Color fundus image: 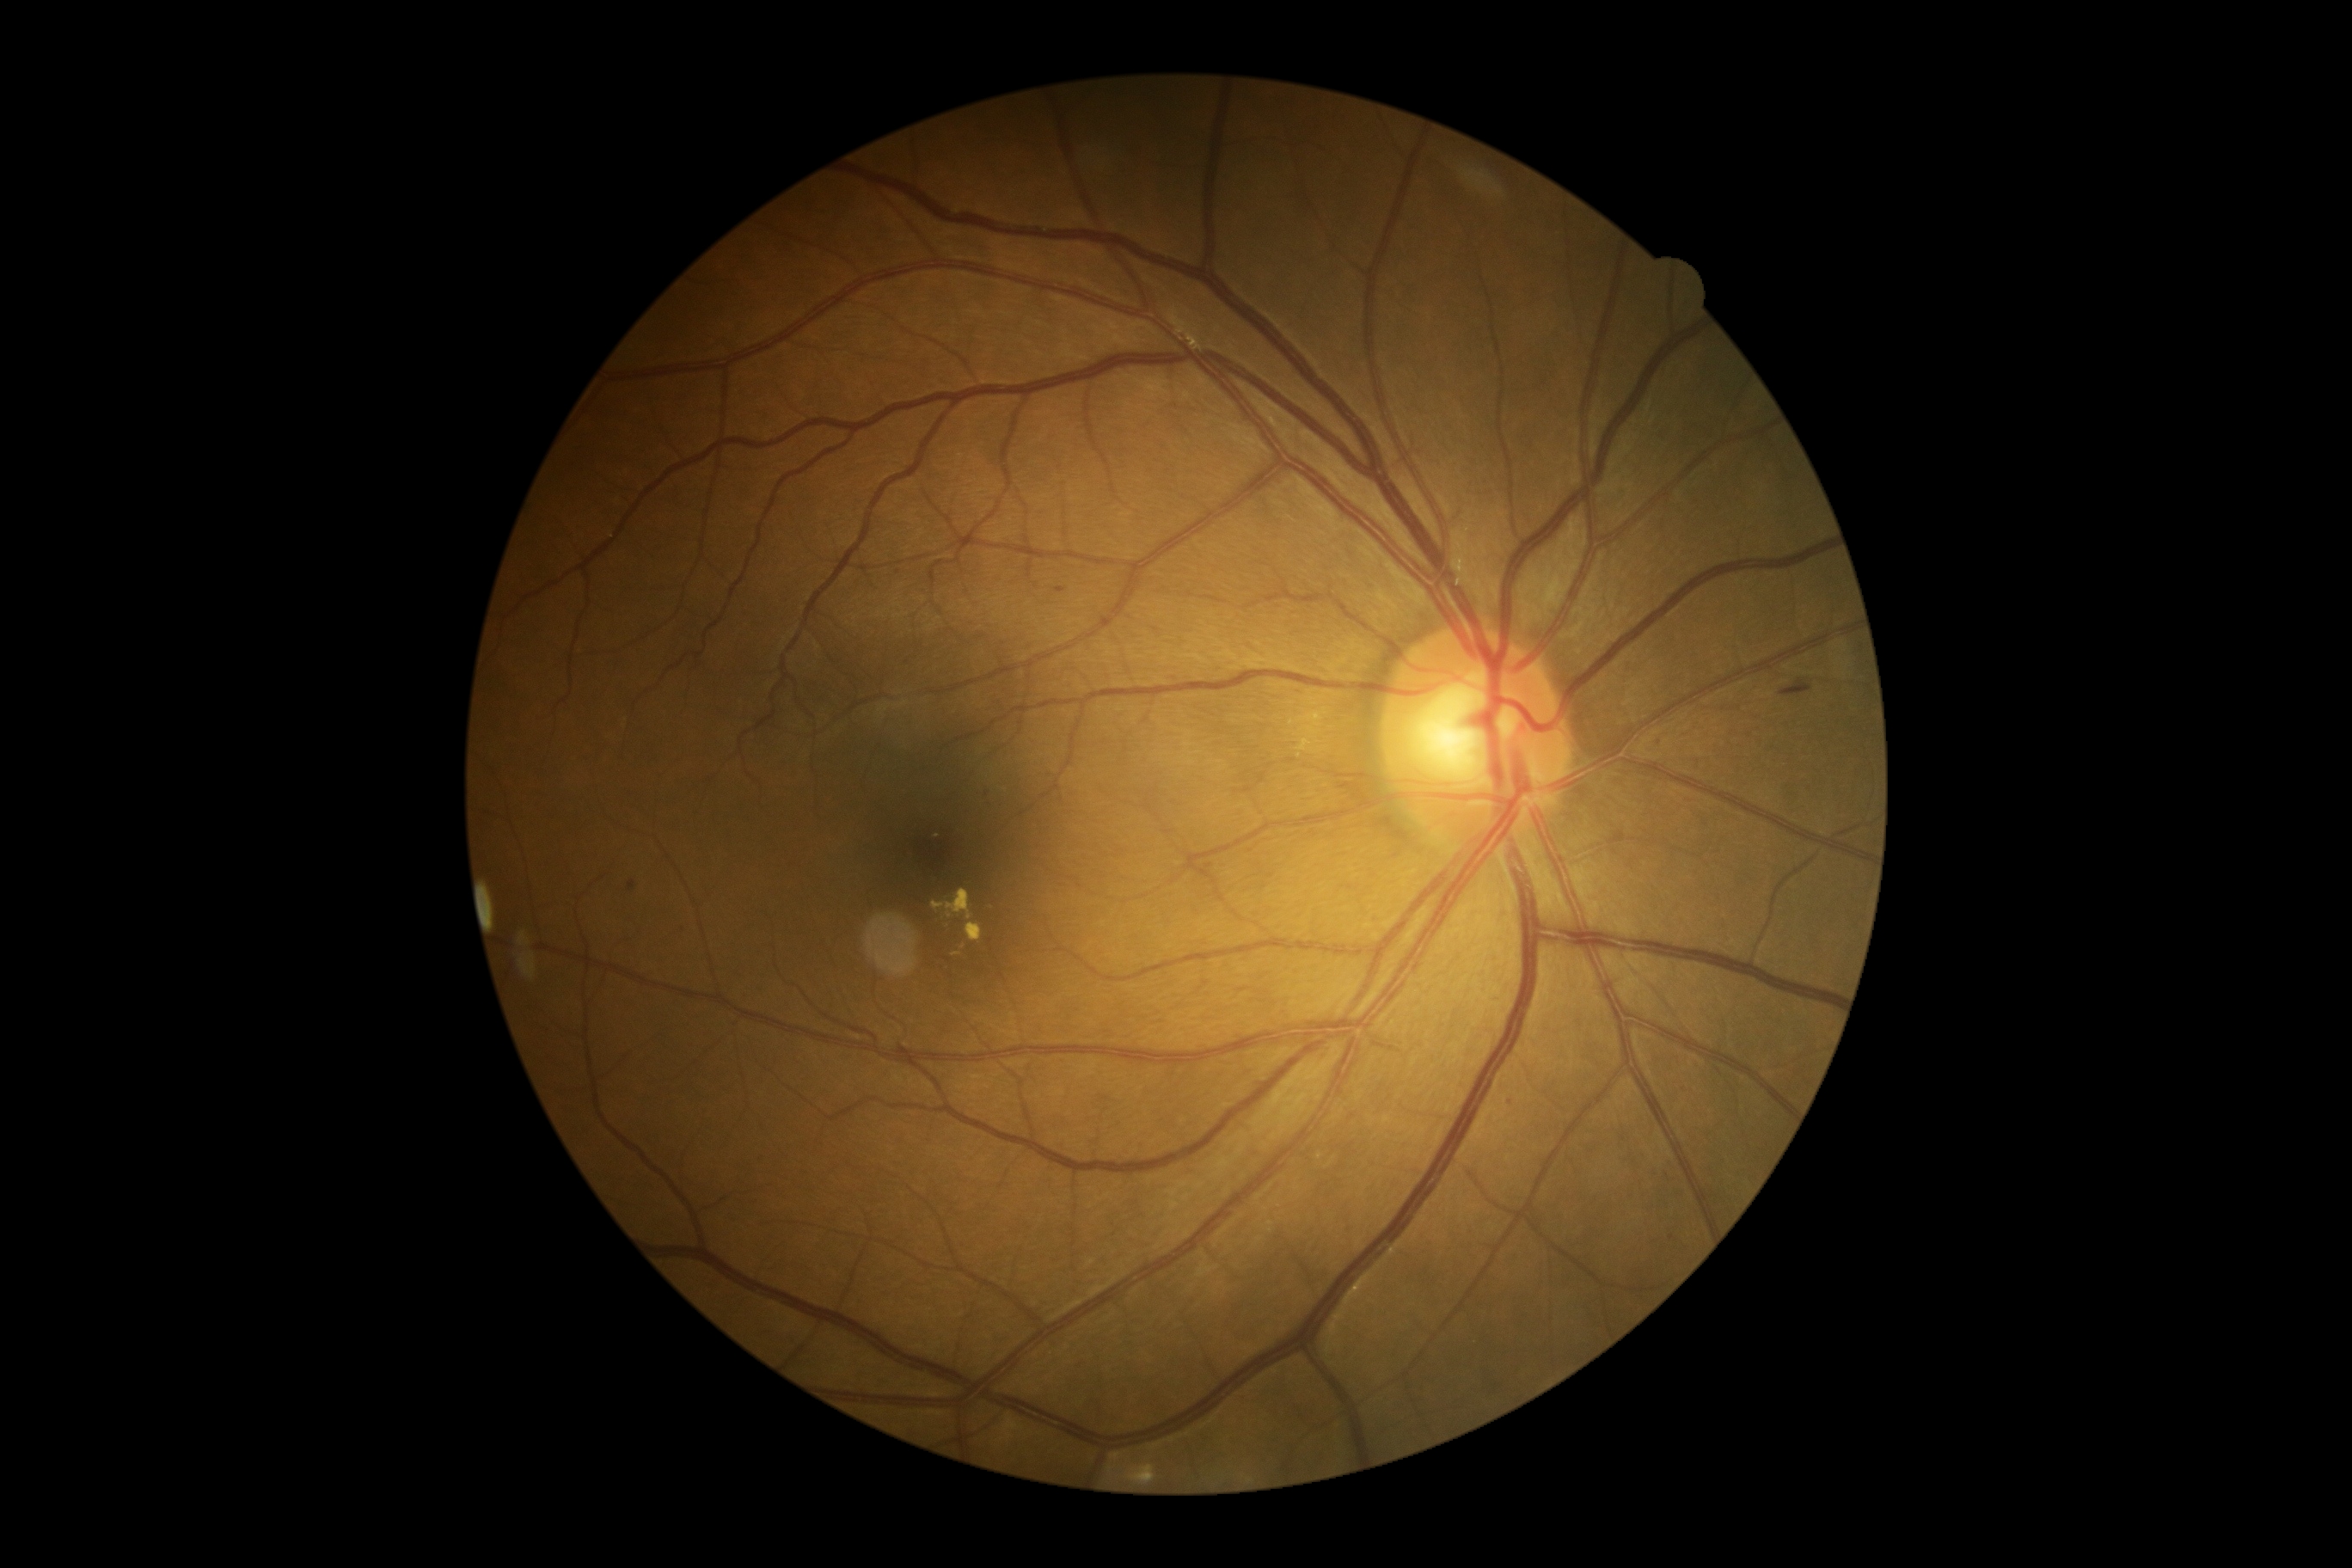

<lesions>
  <dr_grade>2</dr_grade>
  <he>x1=1057, y1=589, x2=1065, y2=594 | x1=628, y1=881, x2=637, y2=891 | x1=1780, y1=680, x2=1813, y2=697</he>
  <ma>x1=1507, y1=1099, x2=1516, y2=1108 | x1=1653, y1=737, x2=1663, y2=744</ma>
  <ex>x1=965, y1=924, x2=983, y2=941 | x1=945, y1=919, x2=948, y2=929 | x1=986, y1=903, x2=995, y2=910 | x1=933, y1=888, x2=974, y2=921</ex>
  <ex_small_approx><pt>956,955</pt> | <pt>938,836</pt> | <pt>963,948</pt></ex_small_approx>
  <se />
</lesions>